DR severity per modified Davis staging. NIDEK AFC-230 — 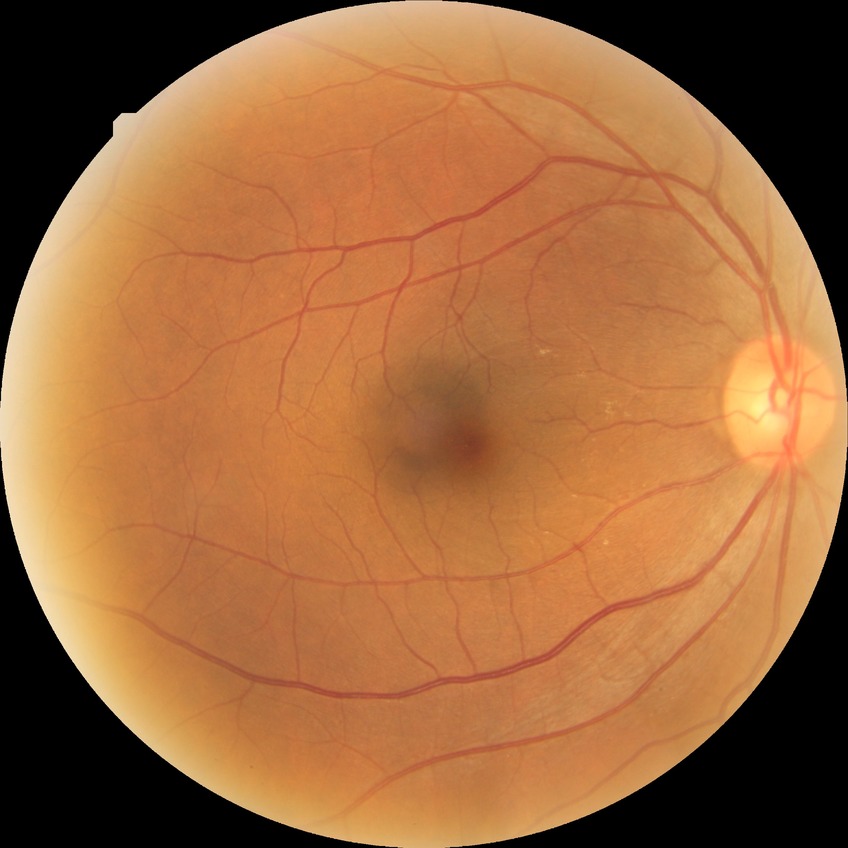 diabetic retinopathy stage=no diabetic retinopathy.